Color fundus image · 45-degree field of view · 2352x1568px:
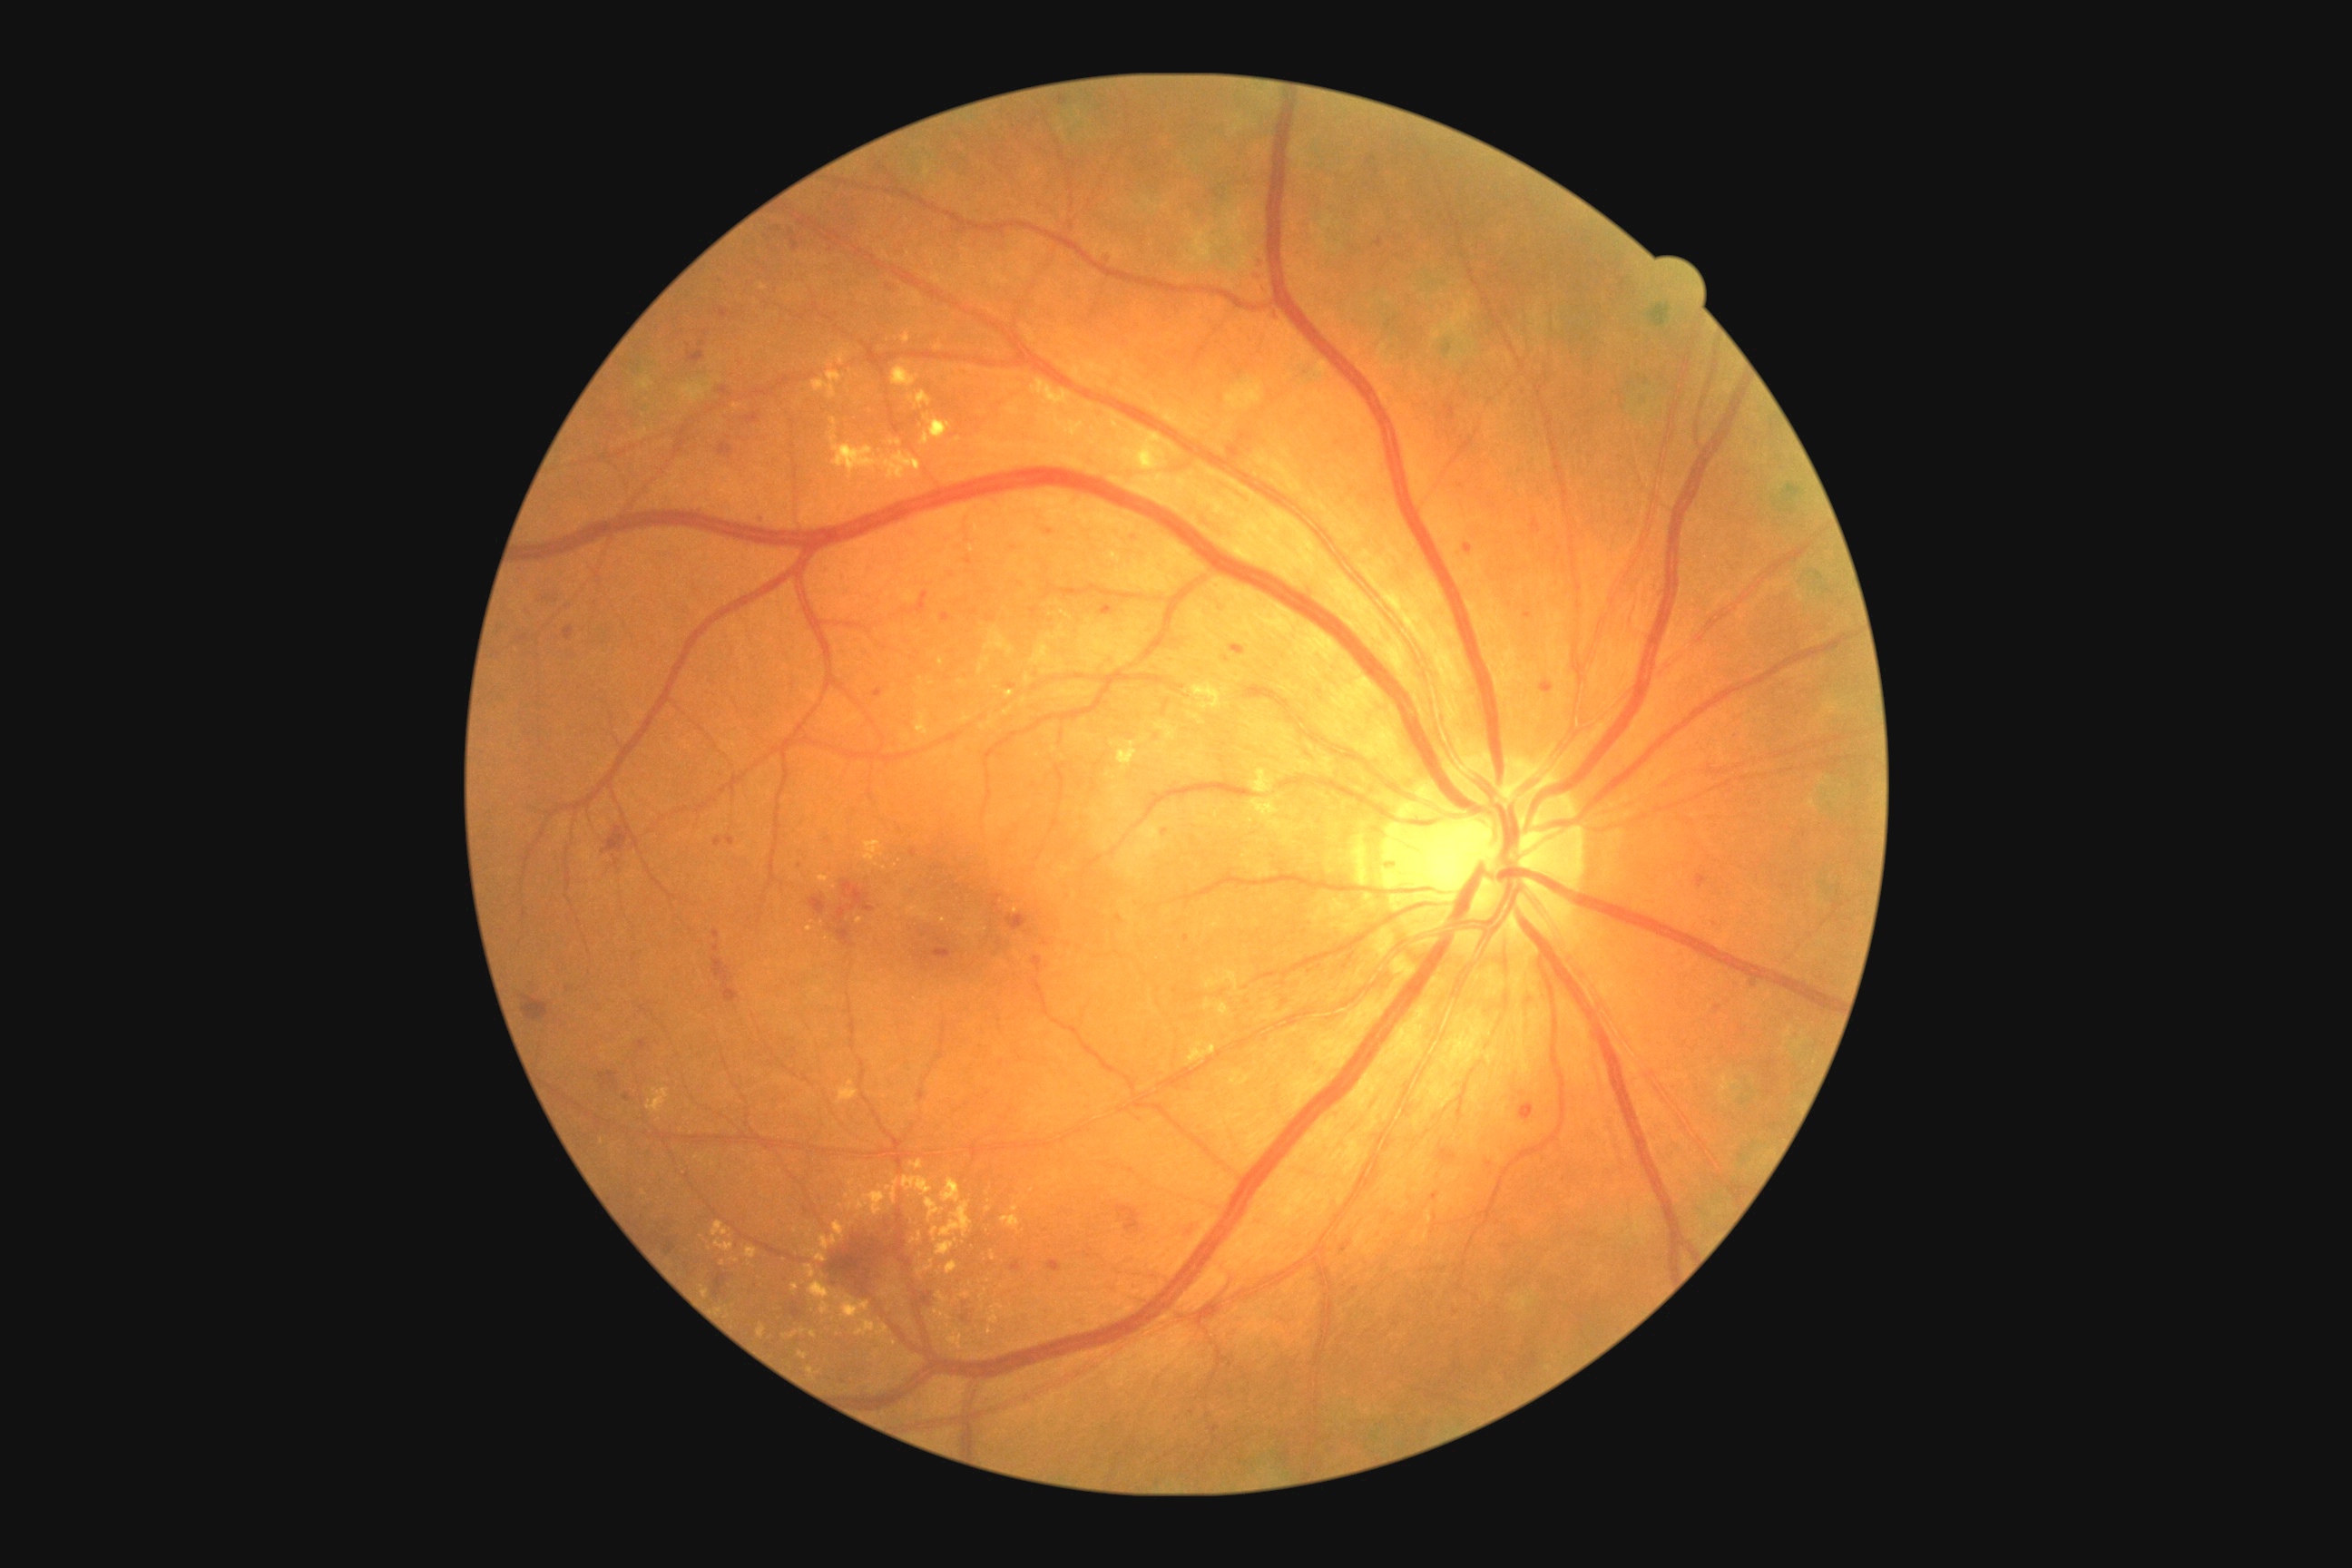
Diabetic retinopathy (DR): grade 2 (moderate NPDR) — more than just microaneurysms but less than severe NPDR
Lesions identified (partial list):
hard exudates (EXs) (partial): bbox=(892, 366, 921, 387); bbox=(917, 1260, 934, 1275); bbox=(1032, 378, 1072, 406); bbox=(910, 1233, 923, 1244); bbox=(970, 545, 975, 553); bbox=(1141, 447, 1157, 471); bbox=(756, 1324, 767, 1338); bbox=(990, 1304, 1004, 1324); bbox=(990, 1251, 995, 1260); bbox=(925, 1199, 945, 1222); bbox=(798, 1351, 808, 1360); bbox=(890, 440, 901, 447); bbox=(1193, 683, 1224, 710)
Smaller EXs around x=644 y=1193; x=922 y=680; x=795 y=1287; x=877 y=865; x=912 y=399; x=721 y=1311
microaneurysms (MAs) (partial): bbox=(966, 556, 972, 565); bbox=(636, 1039, 649, 1052); bbox=(1132, 531, 1141, 540); bbox=(941, 614, 952, 622); bbox=(1431, 1191, 1440, 1202); bbox=(1230, 444, 1240, 458); bbox=(1006, 683, 1017, 689); bbox=(910, 848, 917, 858); bbox=(1524, 612, 1531, 620); bbox=(714, 838, 723, 848)
Smaller MAs around x=1035 y=609; x=1227 y=659; x=1107 y=610; x=1263 y=256; x=1191 y=1413; x=1345 y=1247; x=885 y=648